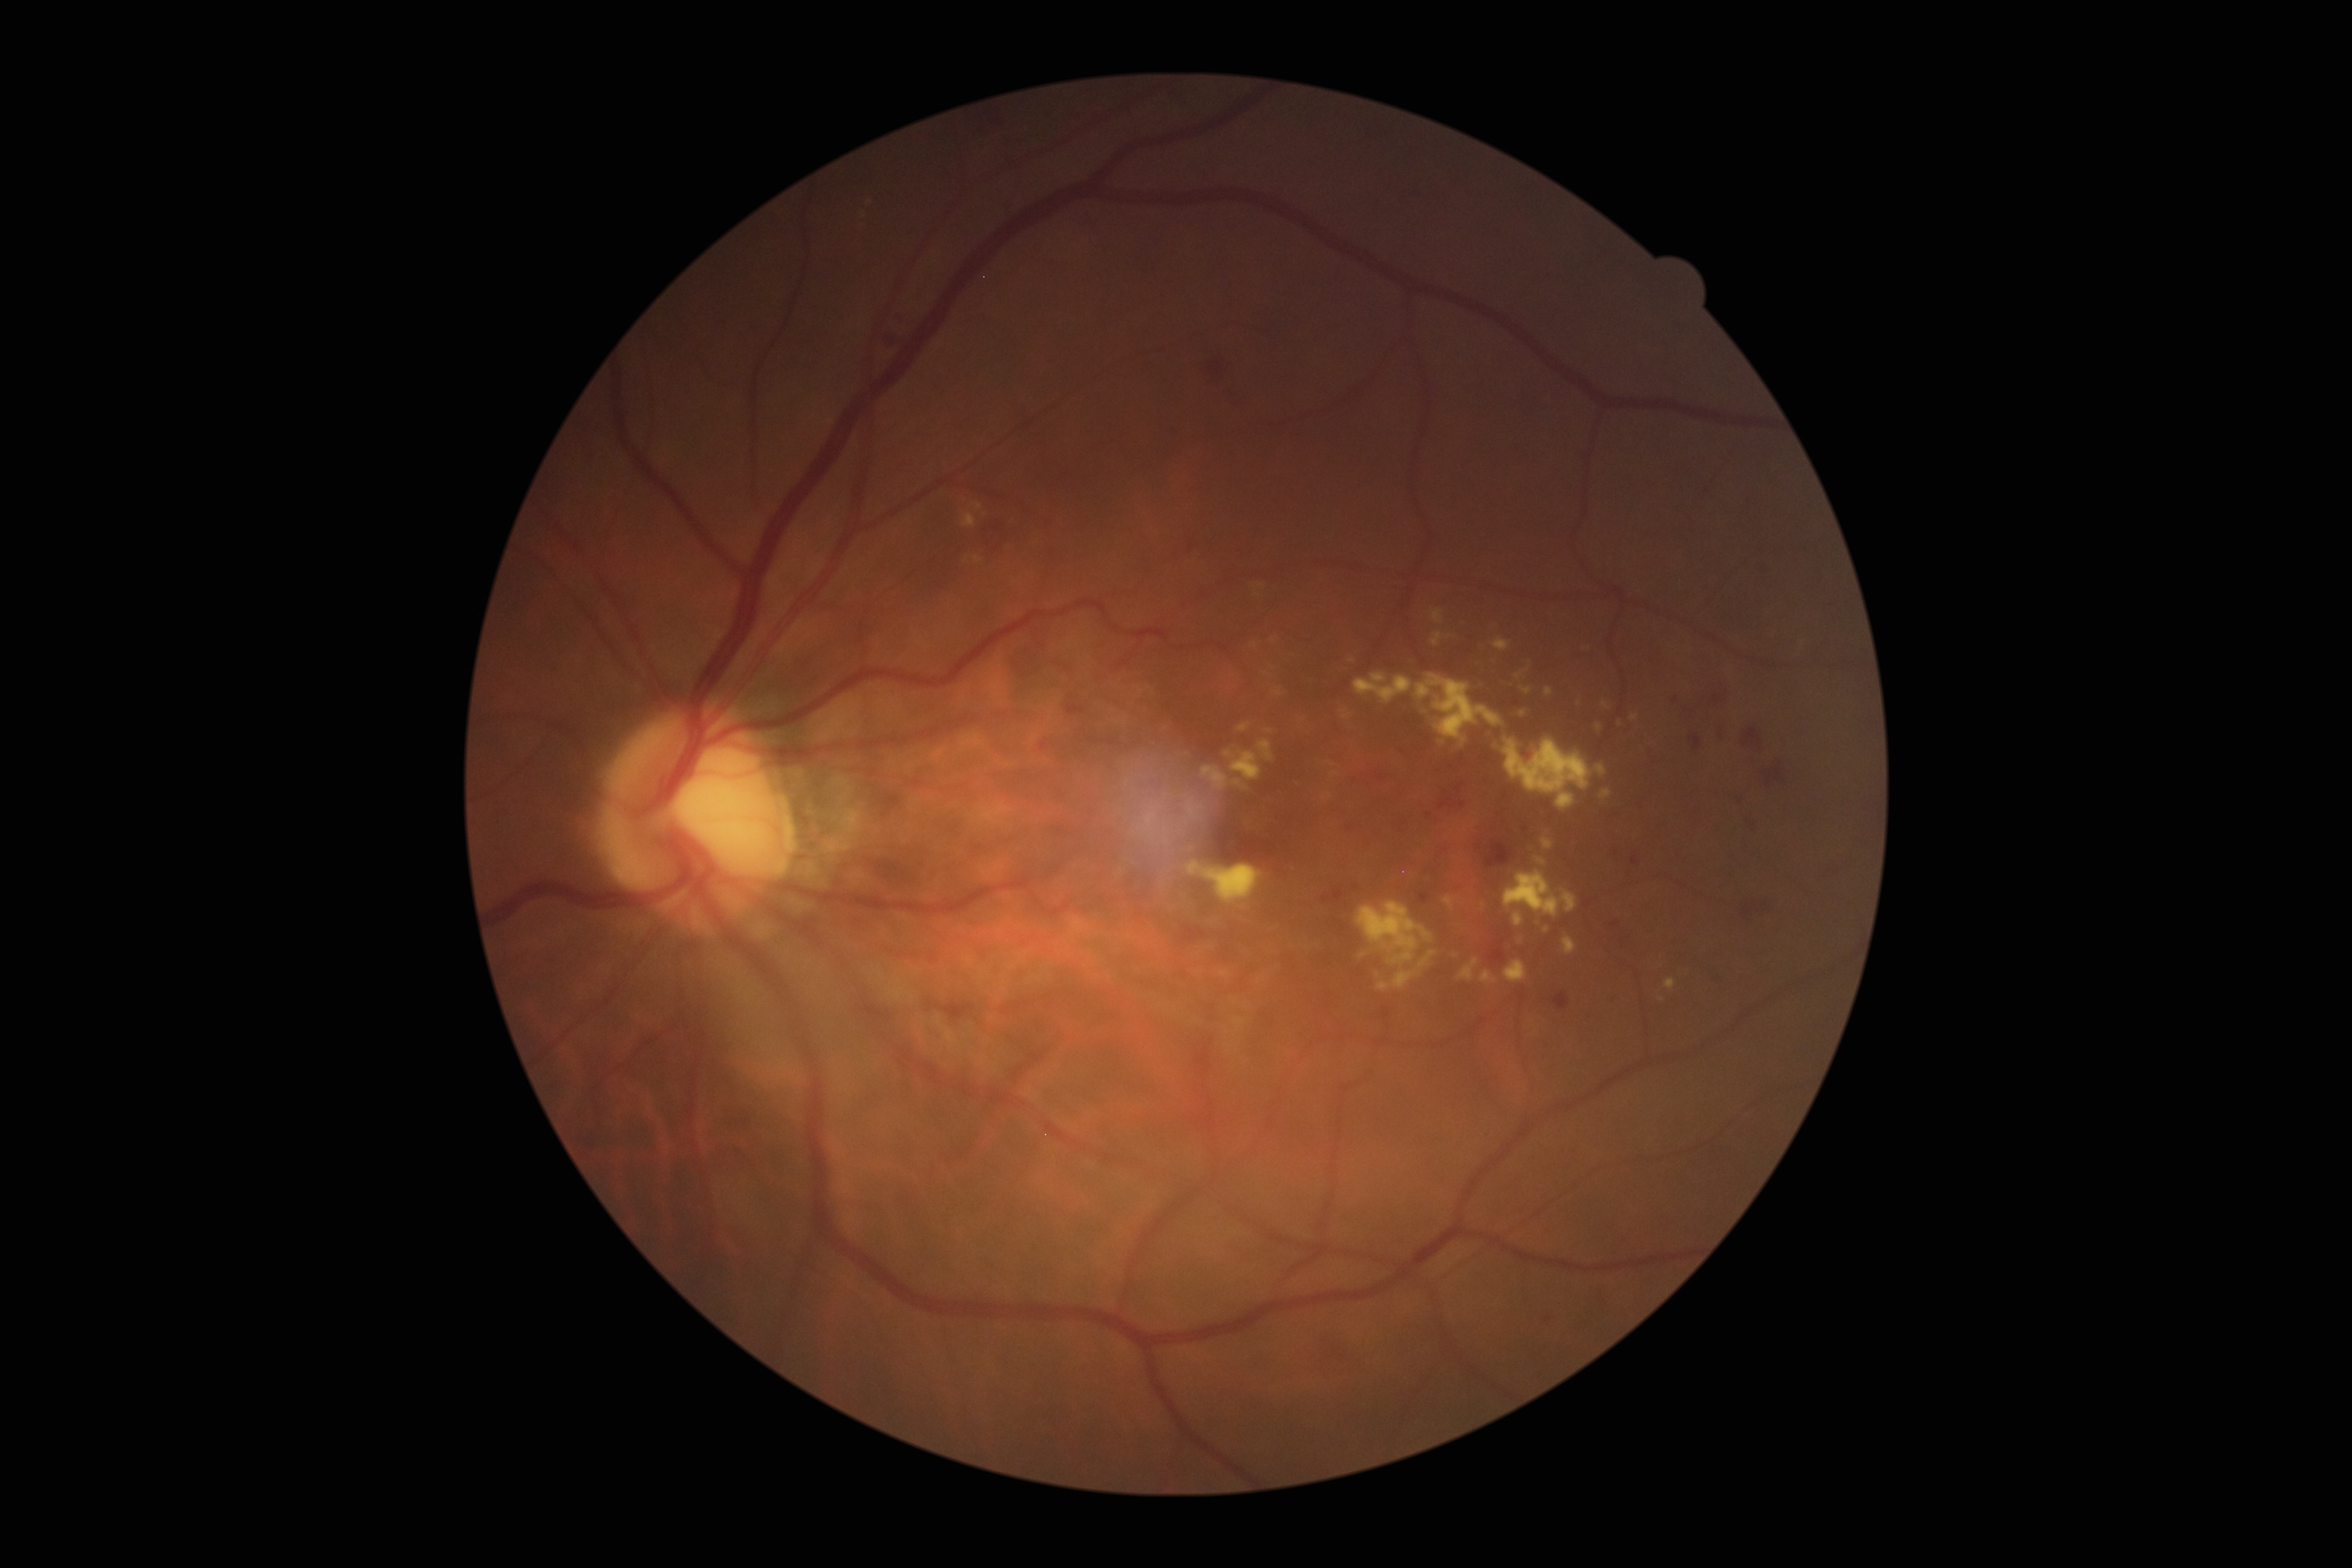
diabetic retinopathy: grade 2 — more than just microaneurysms but less than severe NPDR.